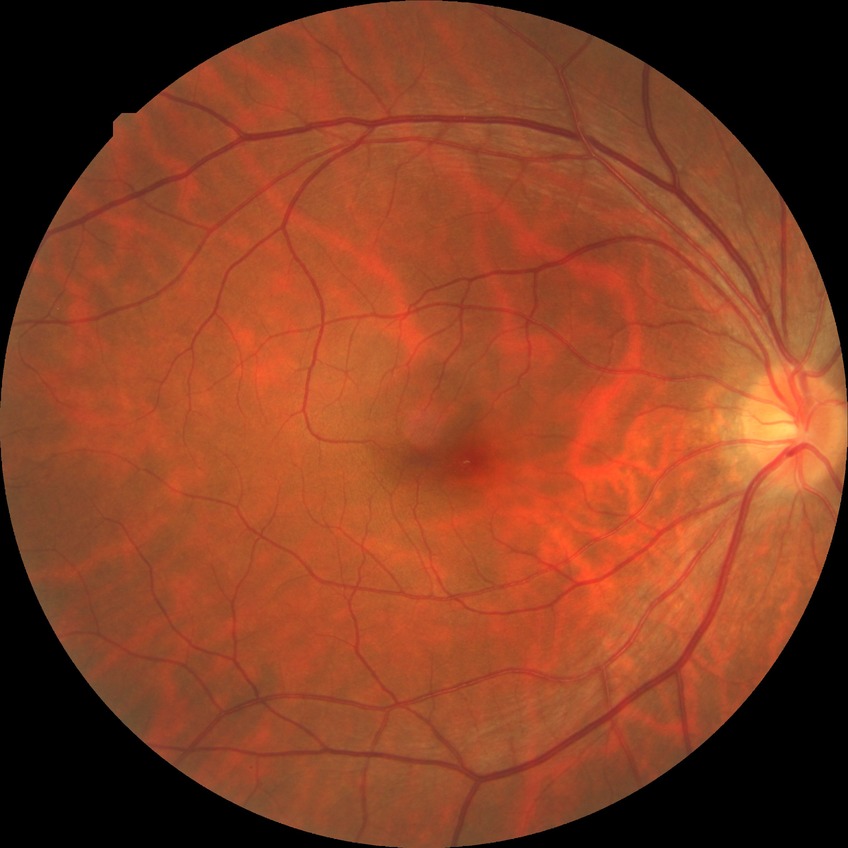
{"davis_grade": "NDR (no diabetic retinopathy)"}